Modified Davis grading · NIDEK AFC-230 fundus camera
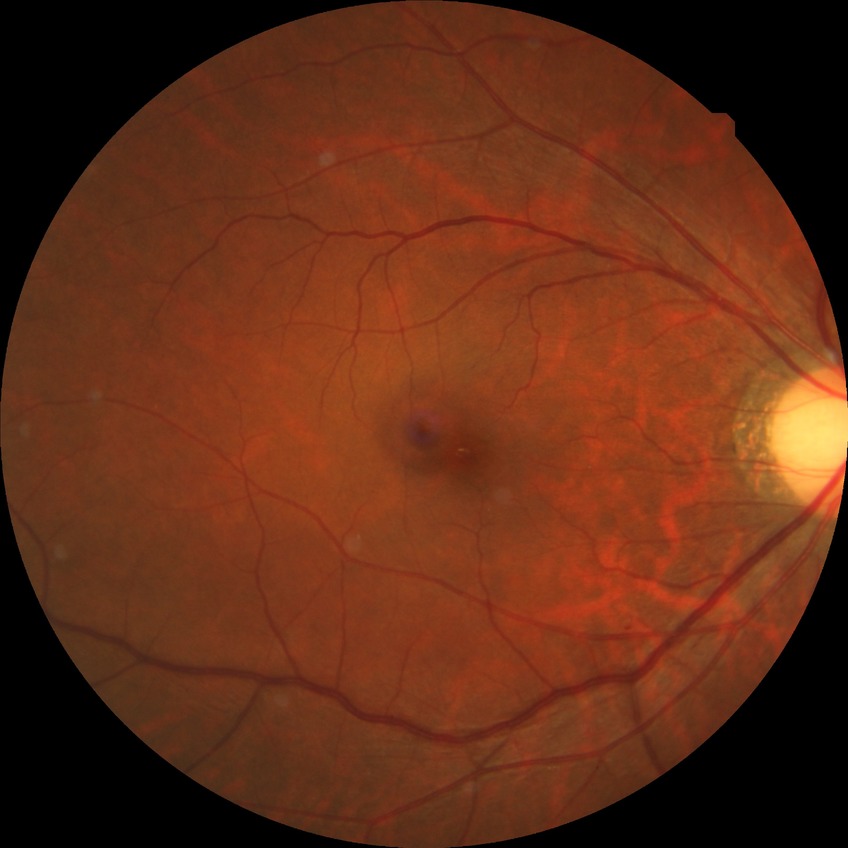 Diabetic retinopathy (DR): no diabetic retinopathy (NDR).